Acquired with a NIDEK AFC-230. CFP
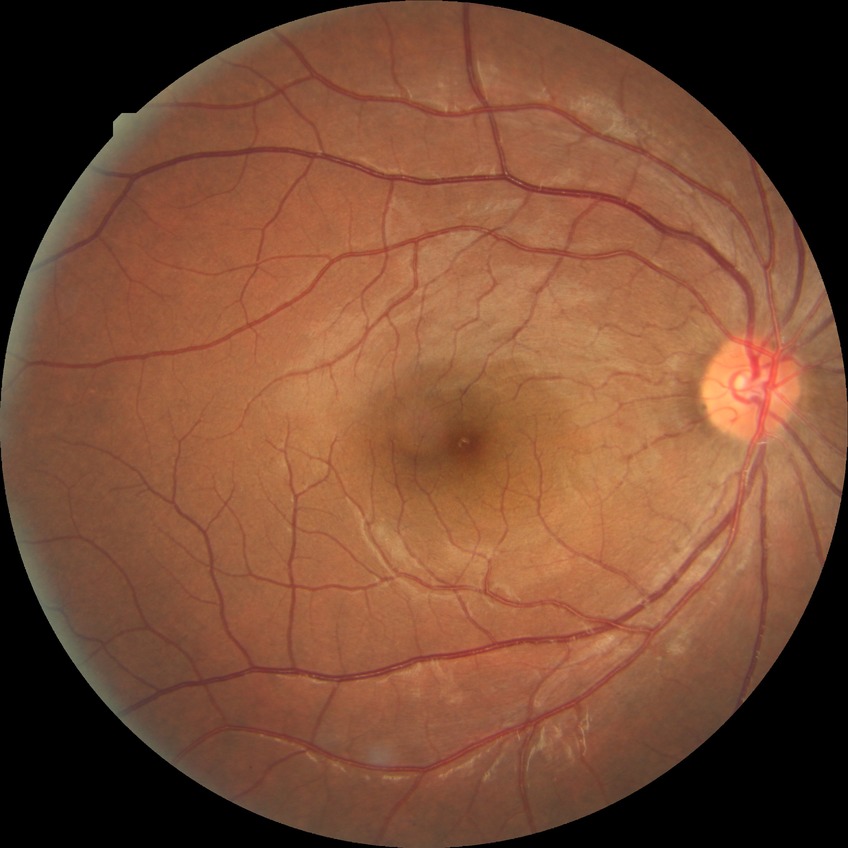 diabetic retinopathy severity = no diabetic retinopathy.